Acquired with a NIDEK AFC-230, graded on the modified Davis scale: 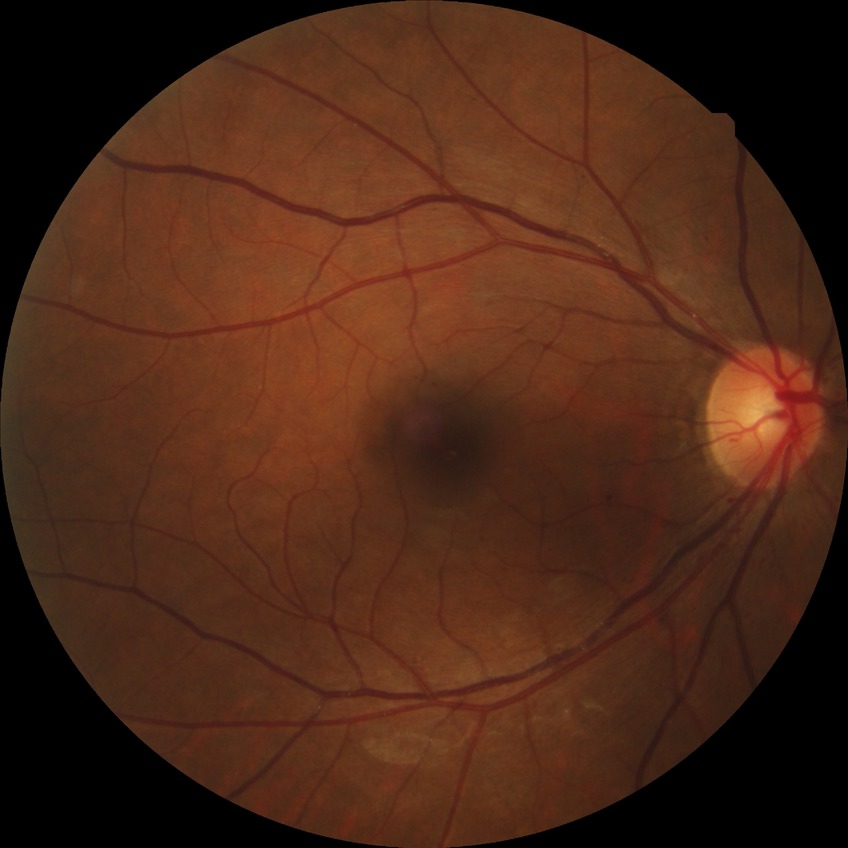
diabetic retinopathy (DR) = no diabetic retinopathy (NDR).